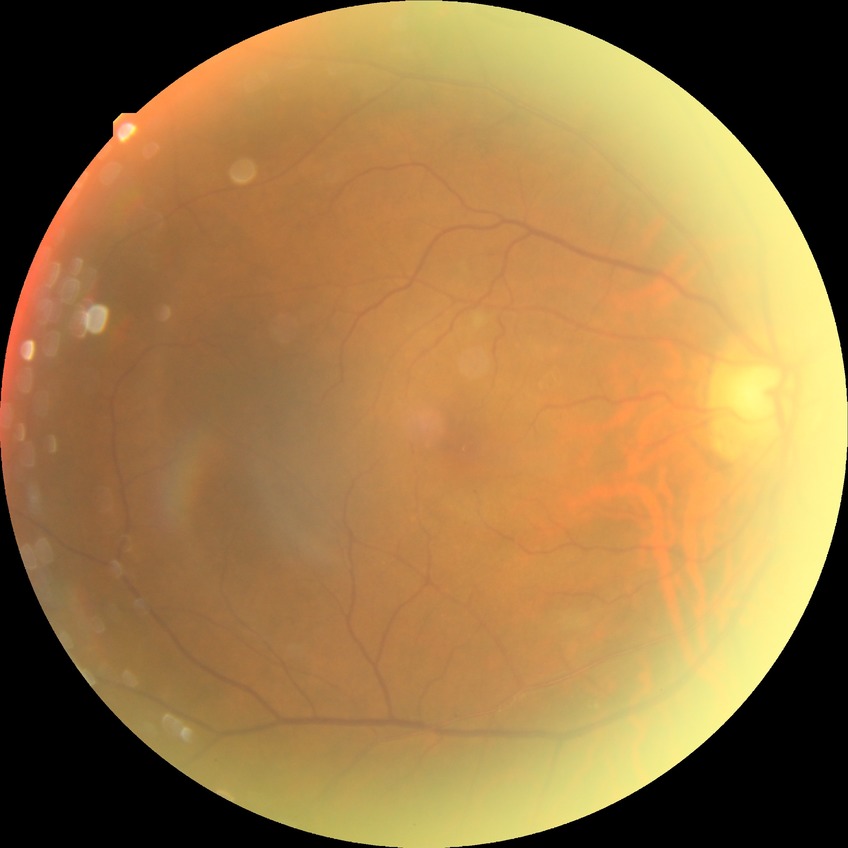

Retinopathy stage: simple diabetic retinopathy.